Infant wide-field fundus photograph. 1240 x 1240 pixels: 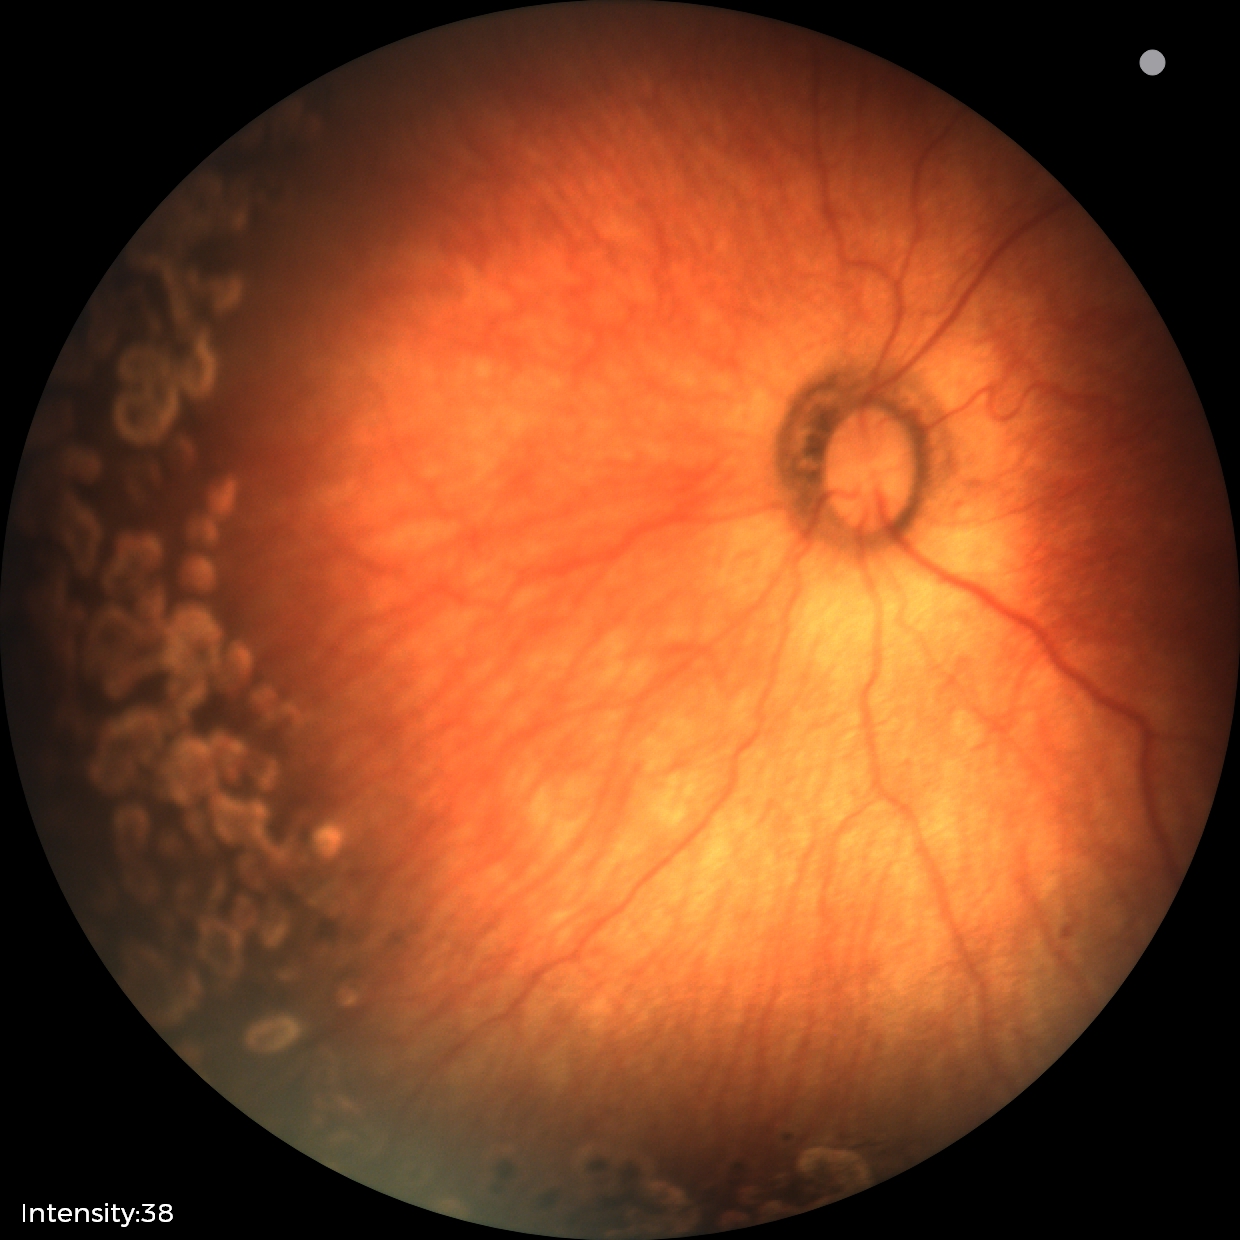

Plus disease = absent
screening diagnosis = status post retinopathy of prematurity (ROP)